Camera: Remidio FOP fundus camera; 1659 x 2212 pixels; color fundus image:
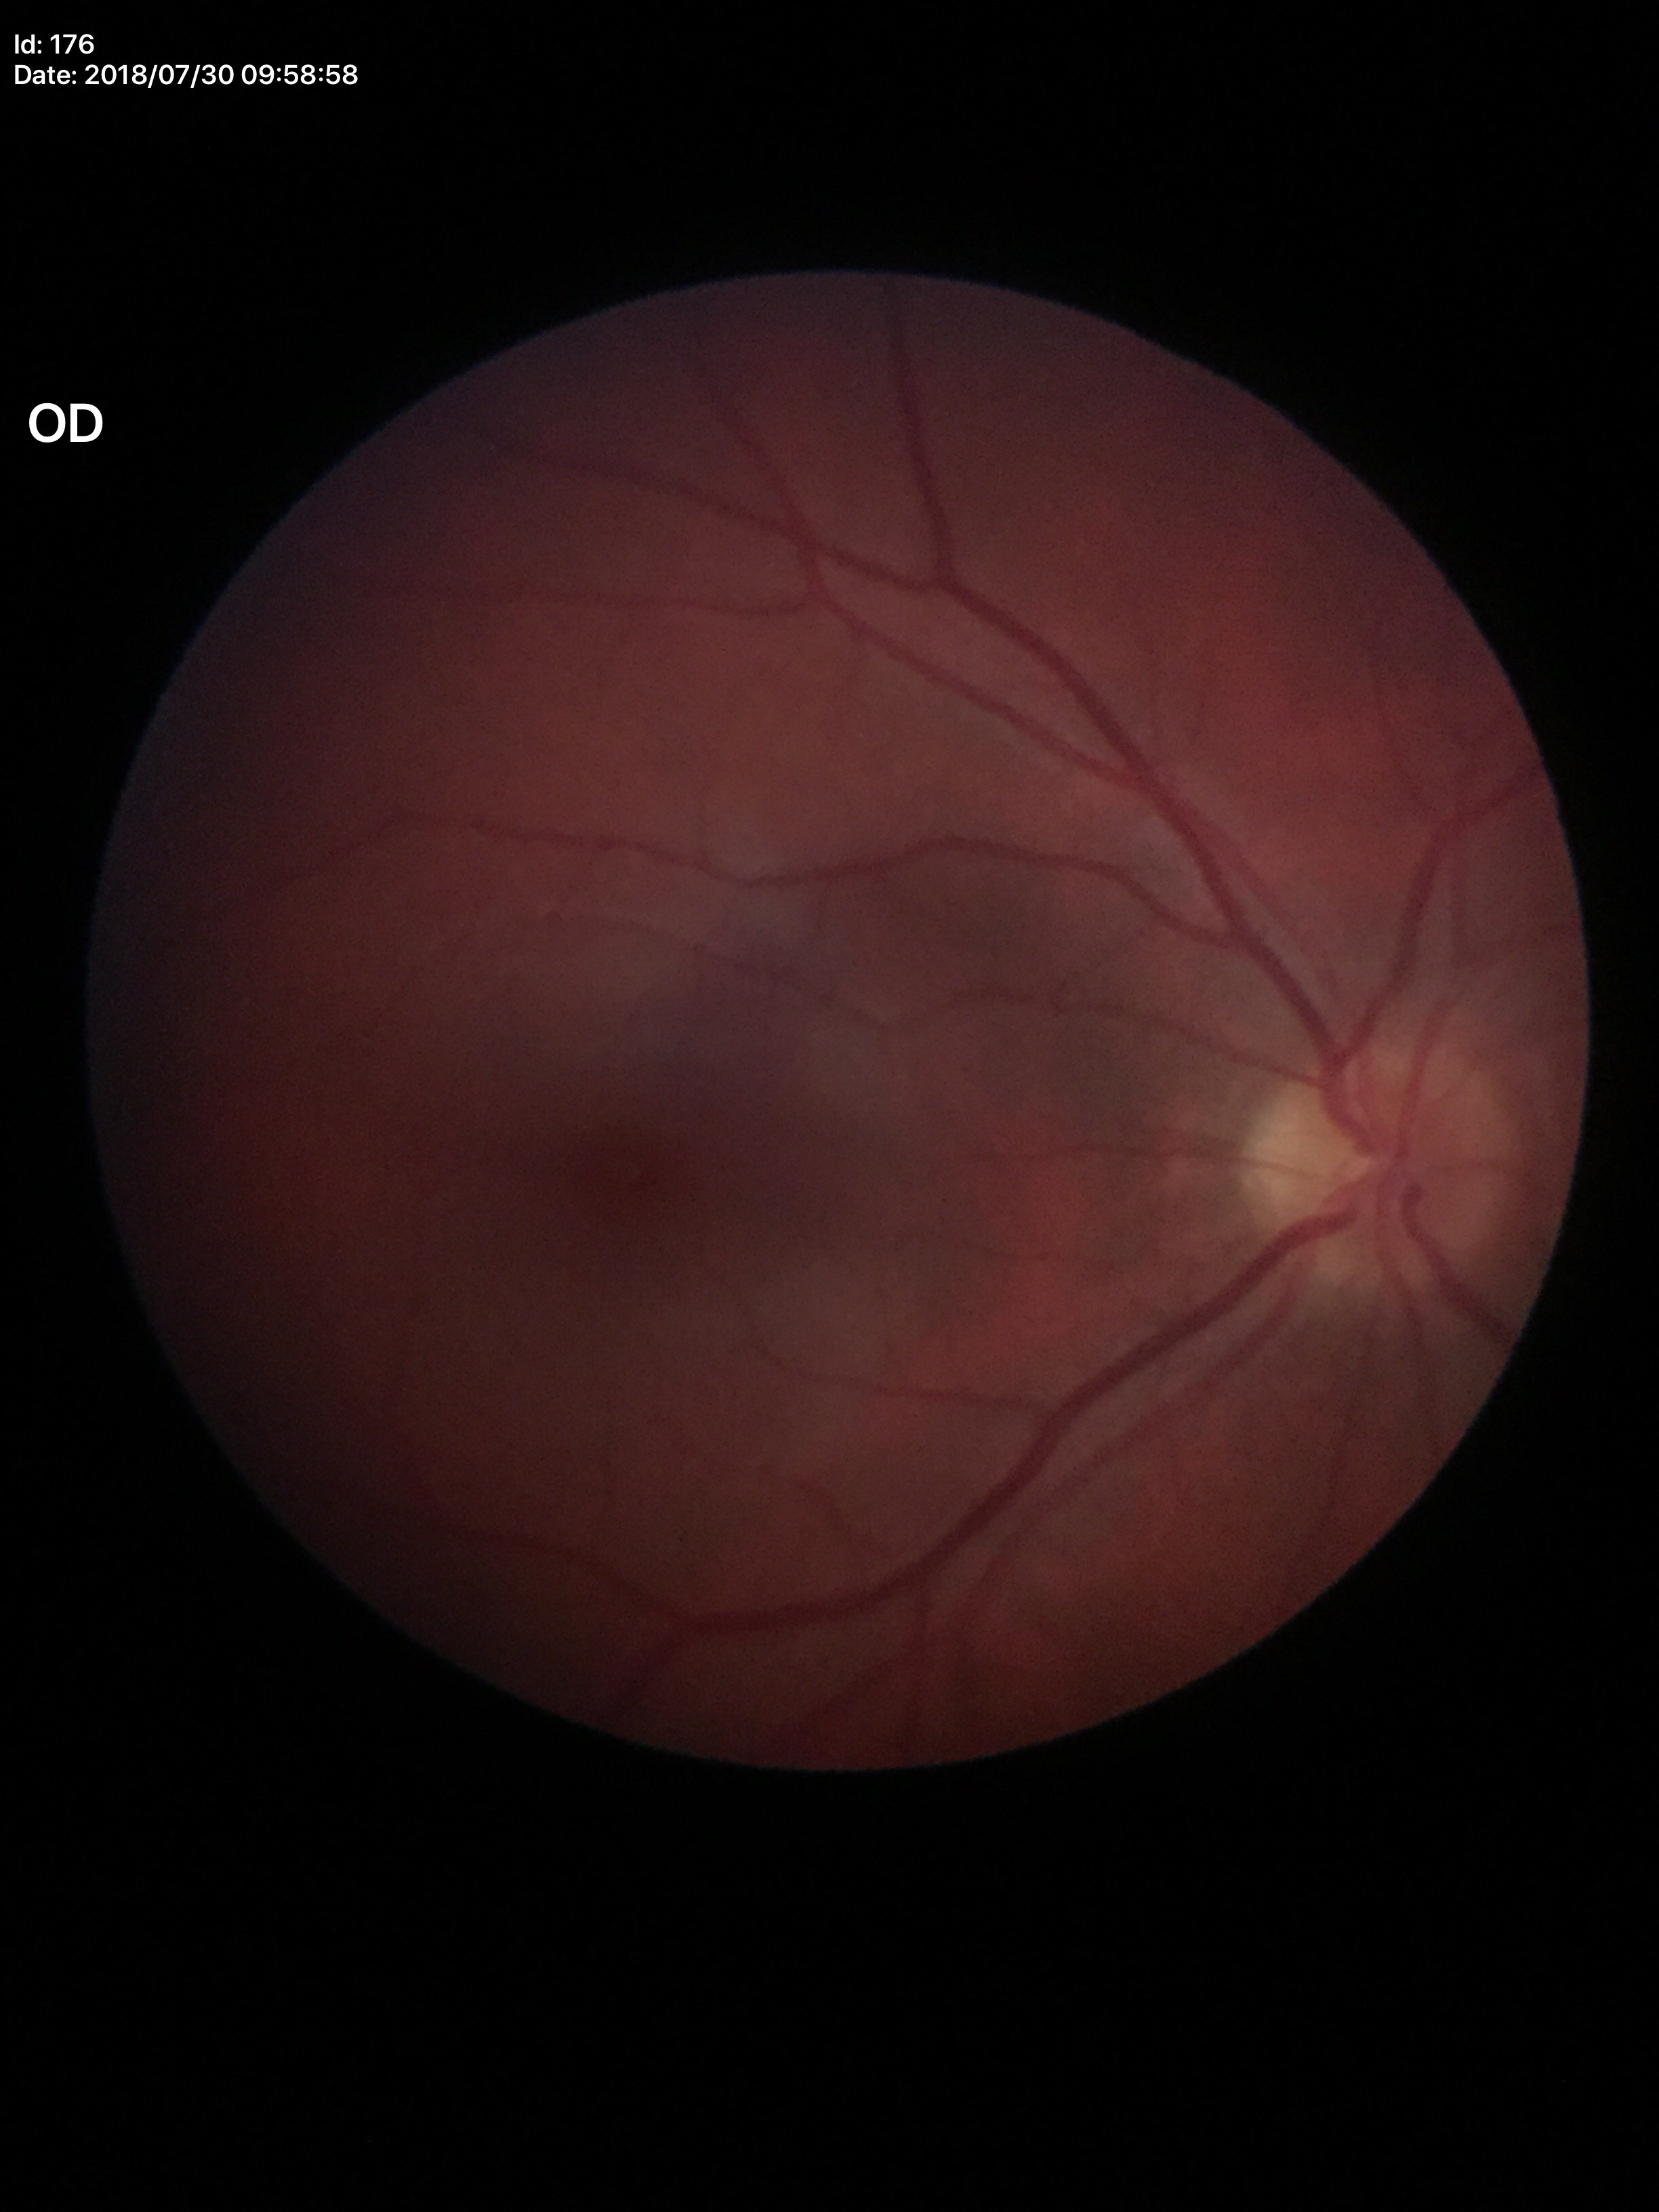
VCDR: 0.39.
HCDR: 0.41.
Glaucoma evaluation: negative.